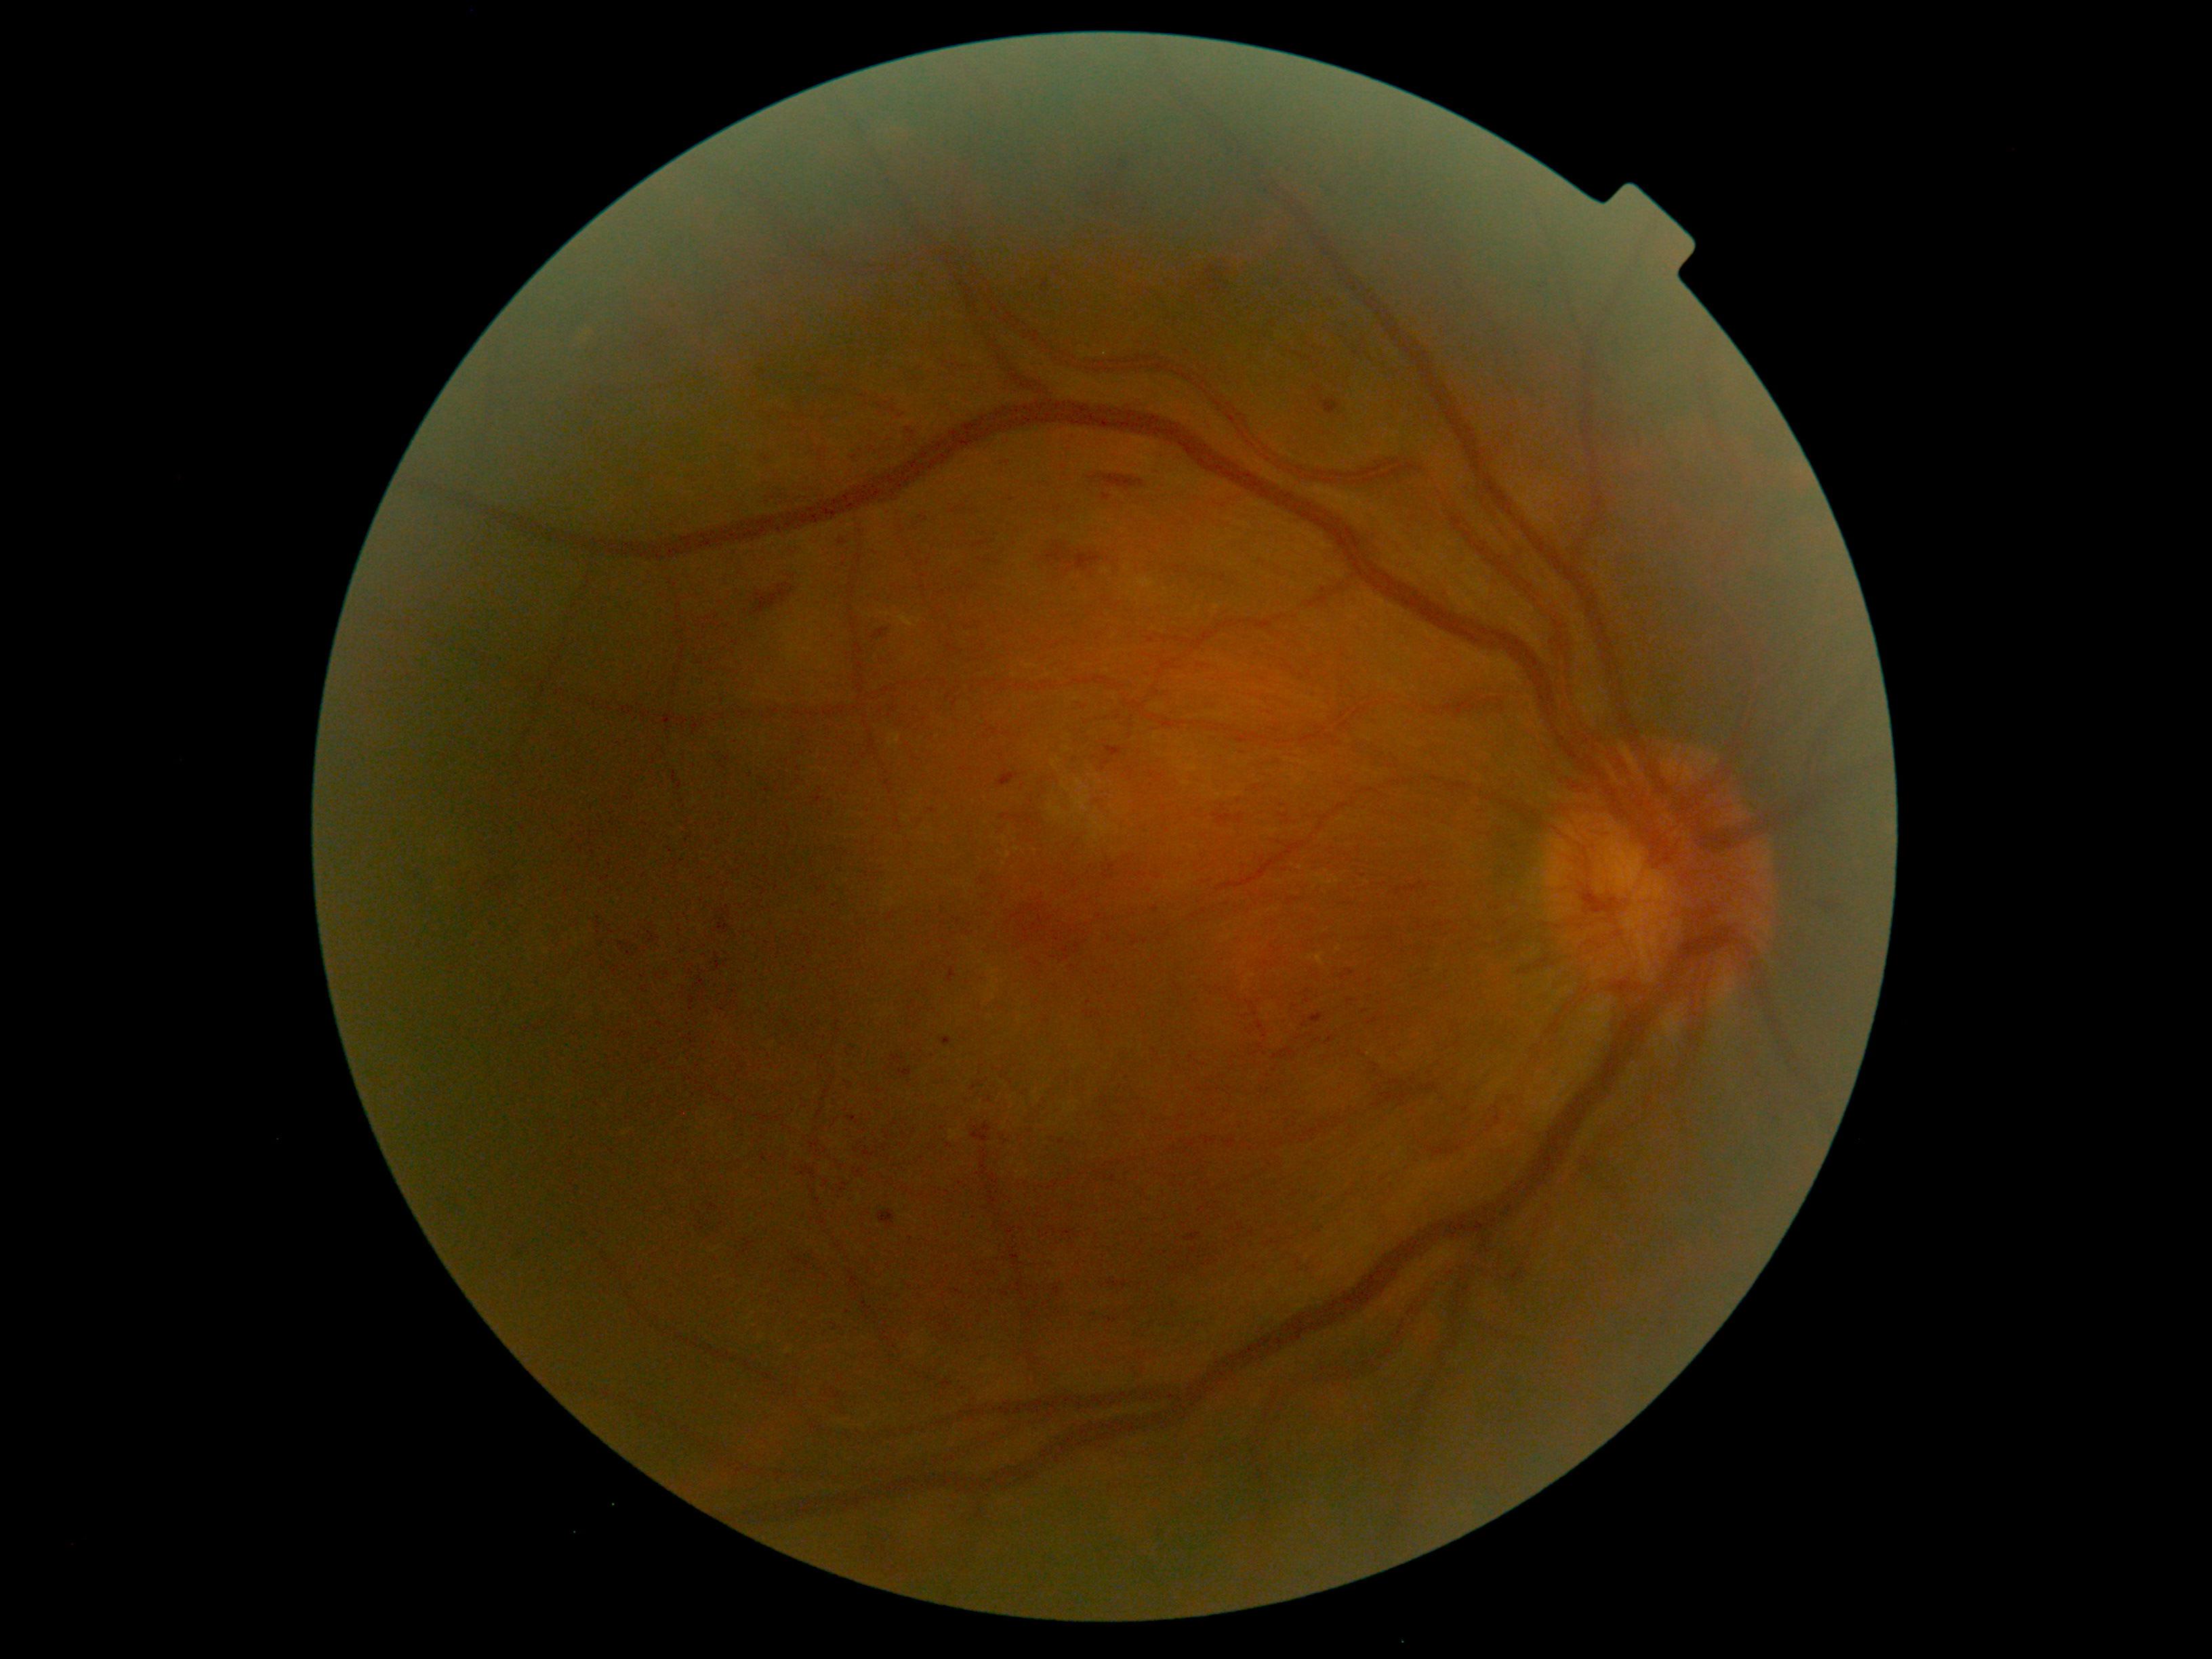
  dr_category: proliferative diabetic retinopathy
  dr_grade: proliferative diabetic retinopathy (grade 4)